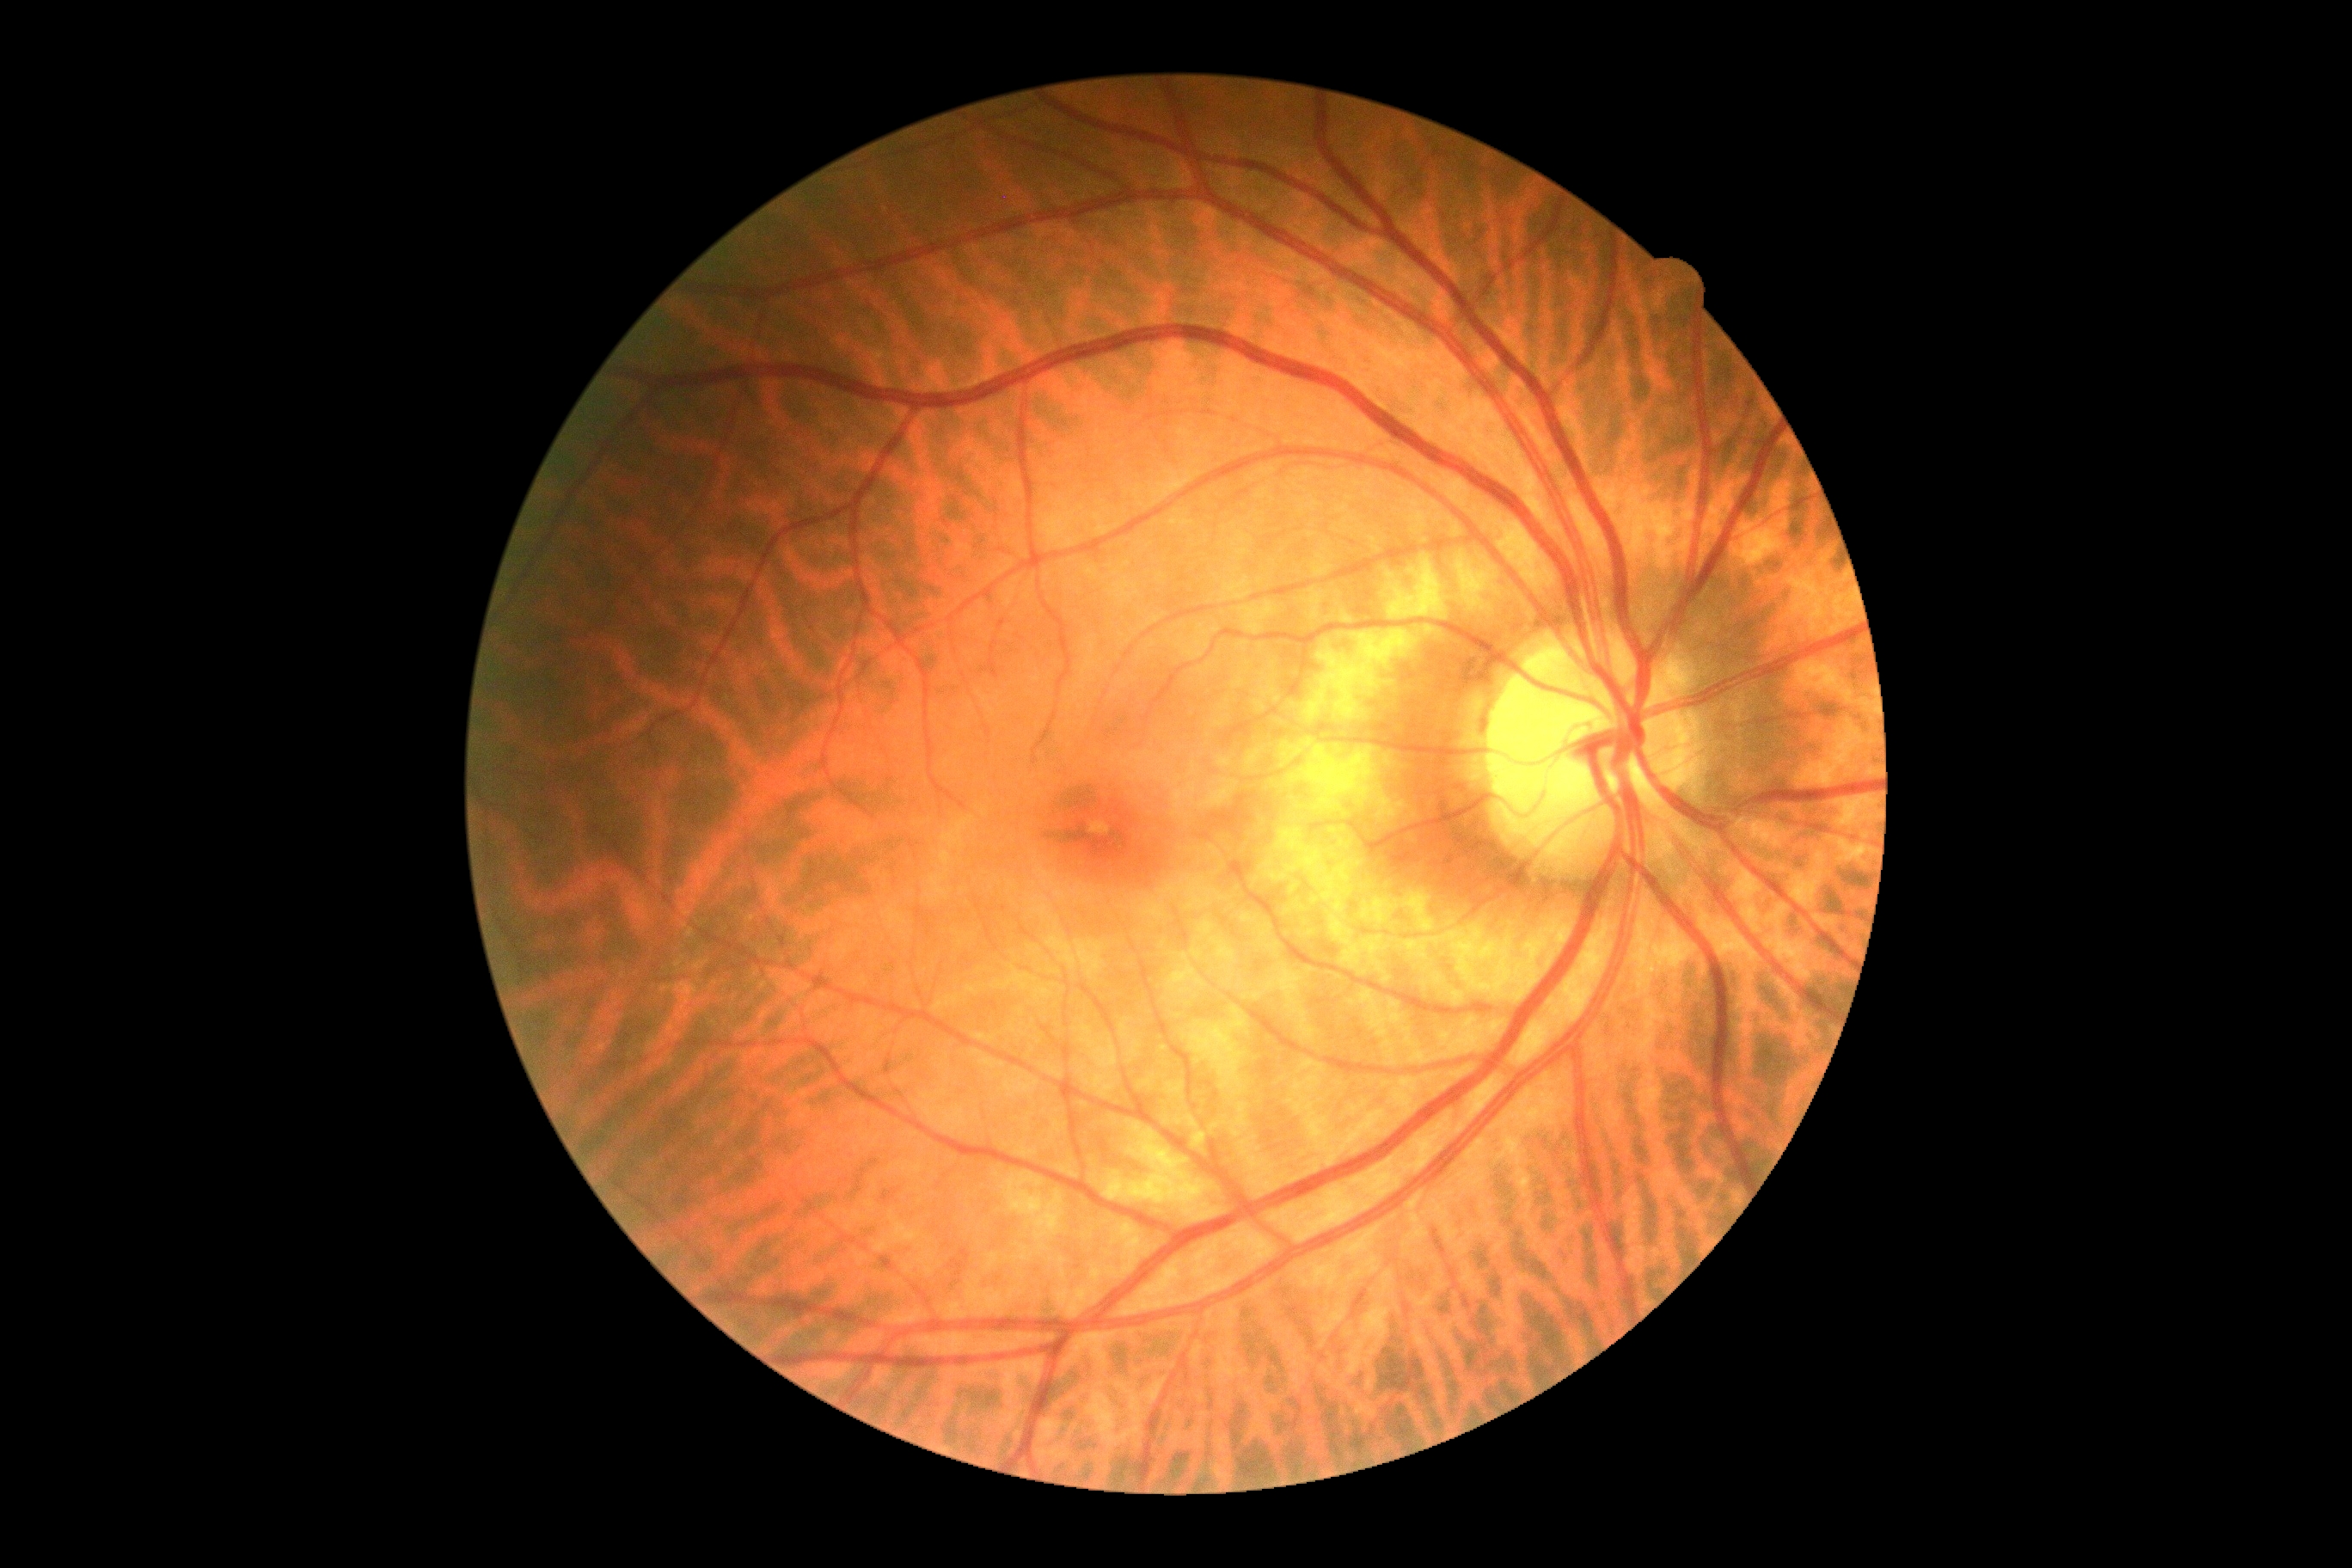 diabetic retinopathy (DR)@0/4 — no visible signs of diabetic retinopathy; DR impression@no signs of DR.